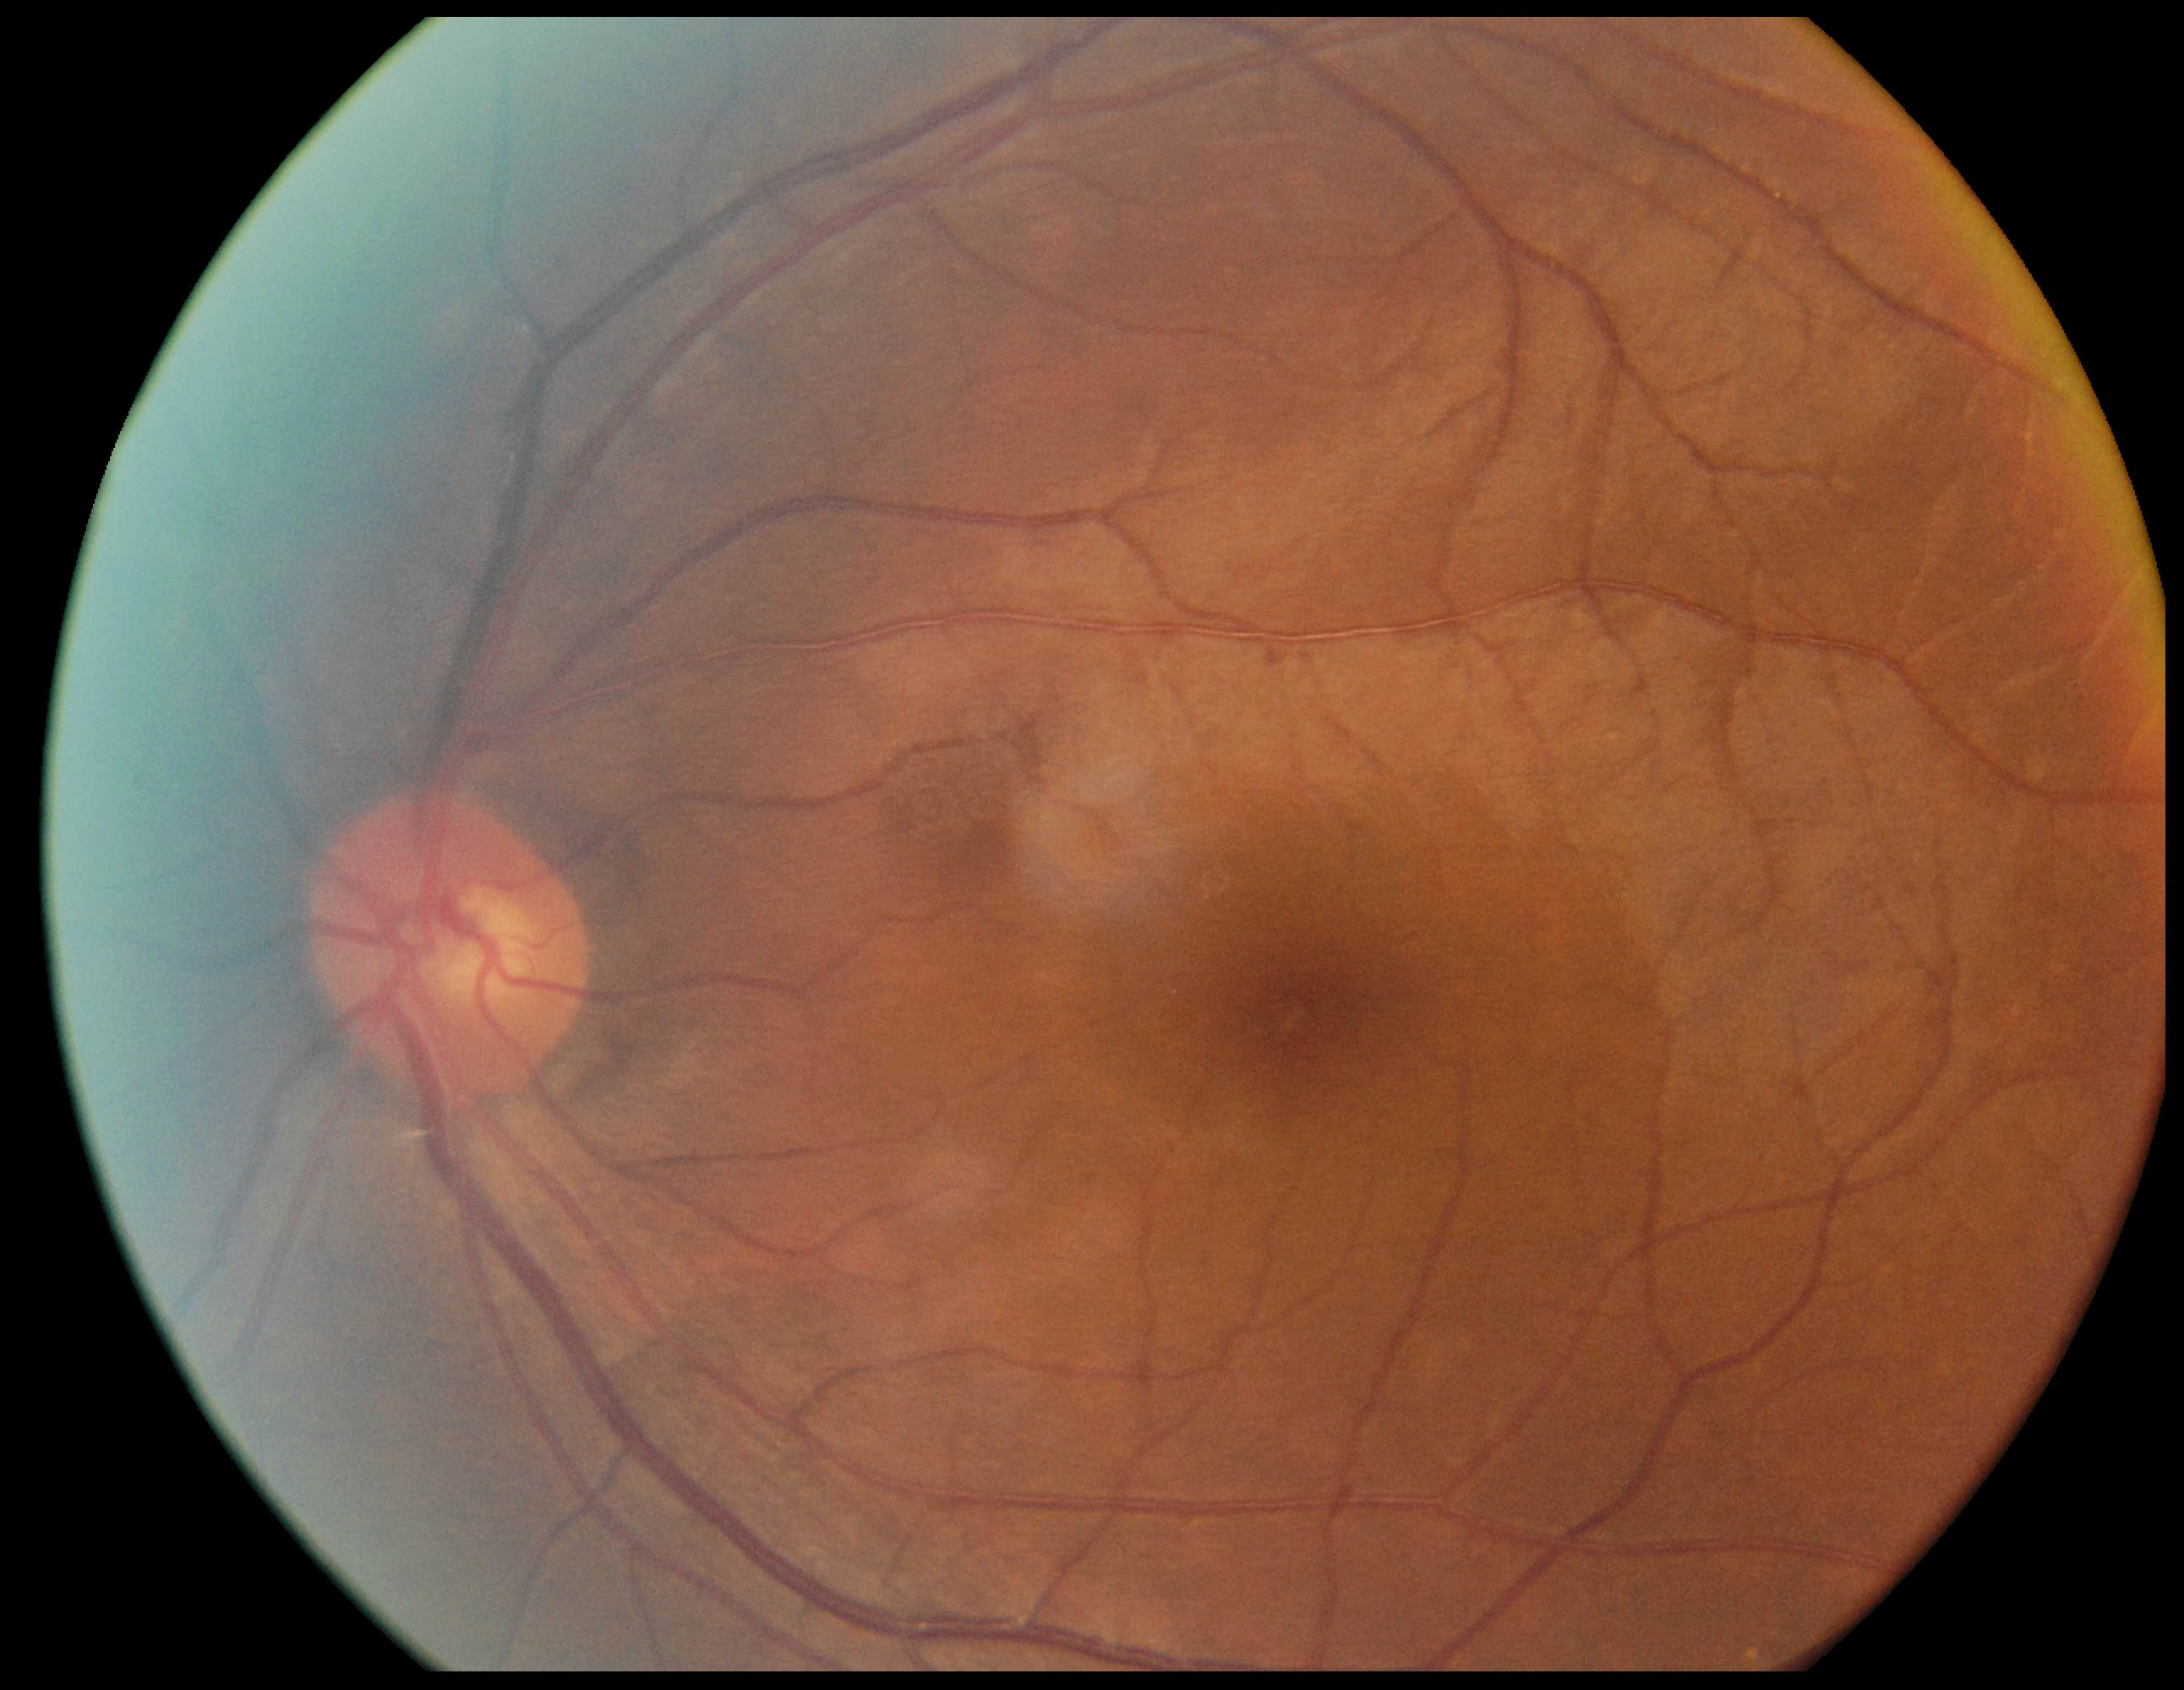

DR severity is 0. No diabetic retinal disease findings.